200° field of view · ultra-widefield fundus photograph.
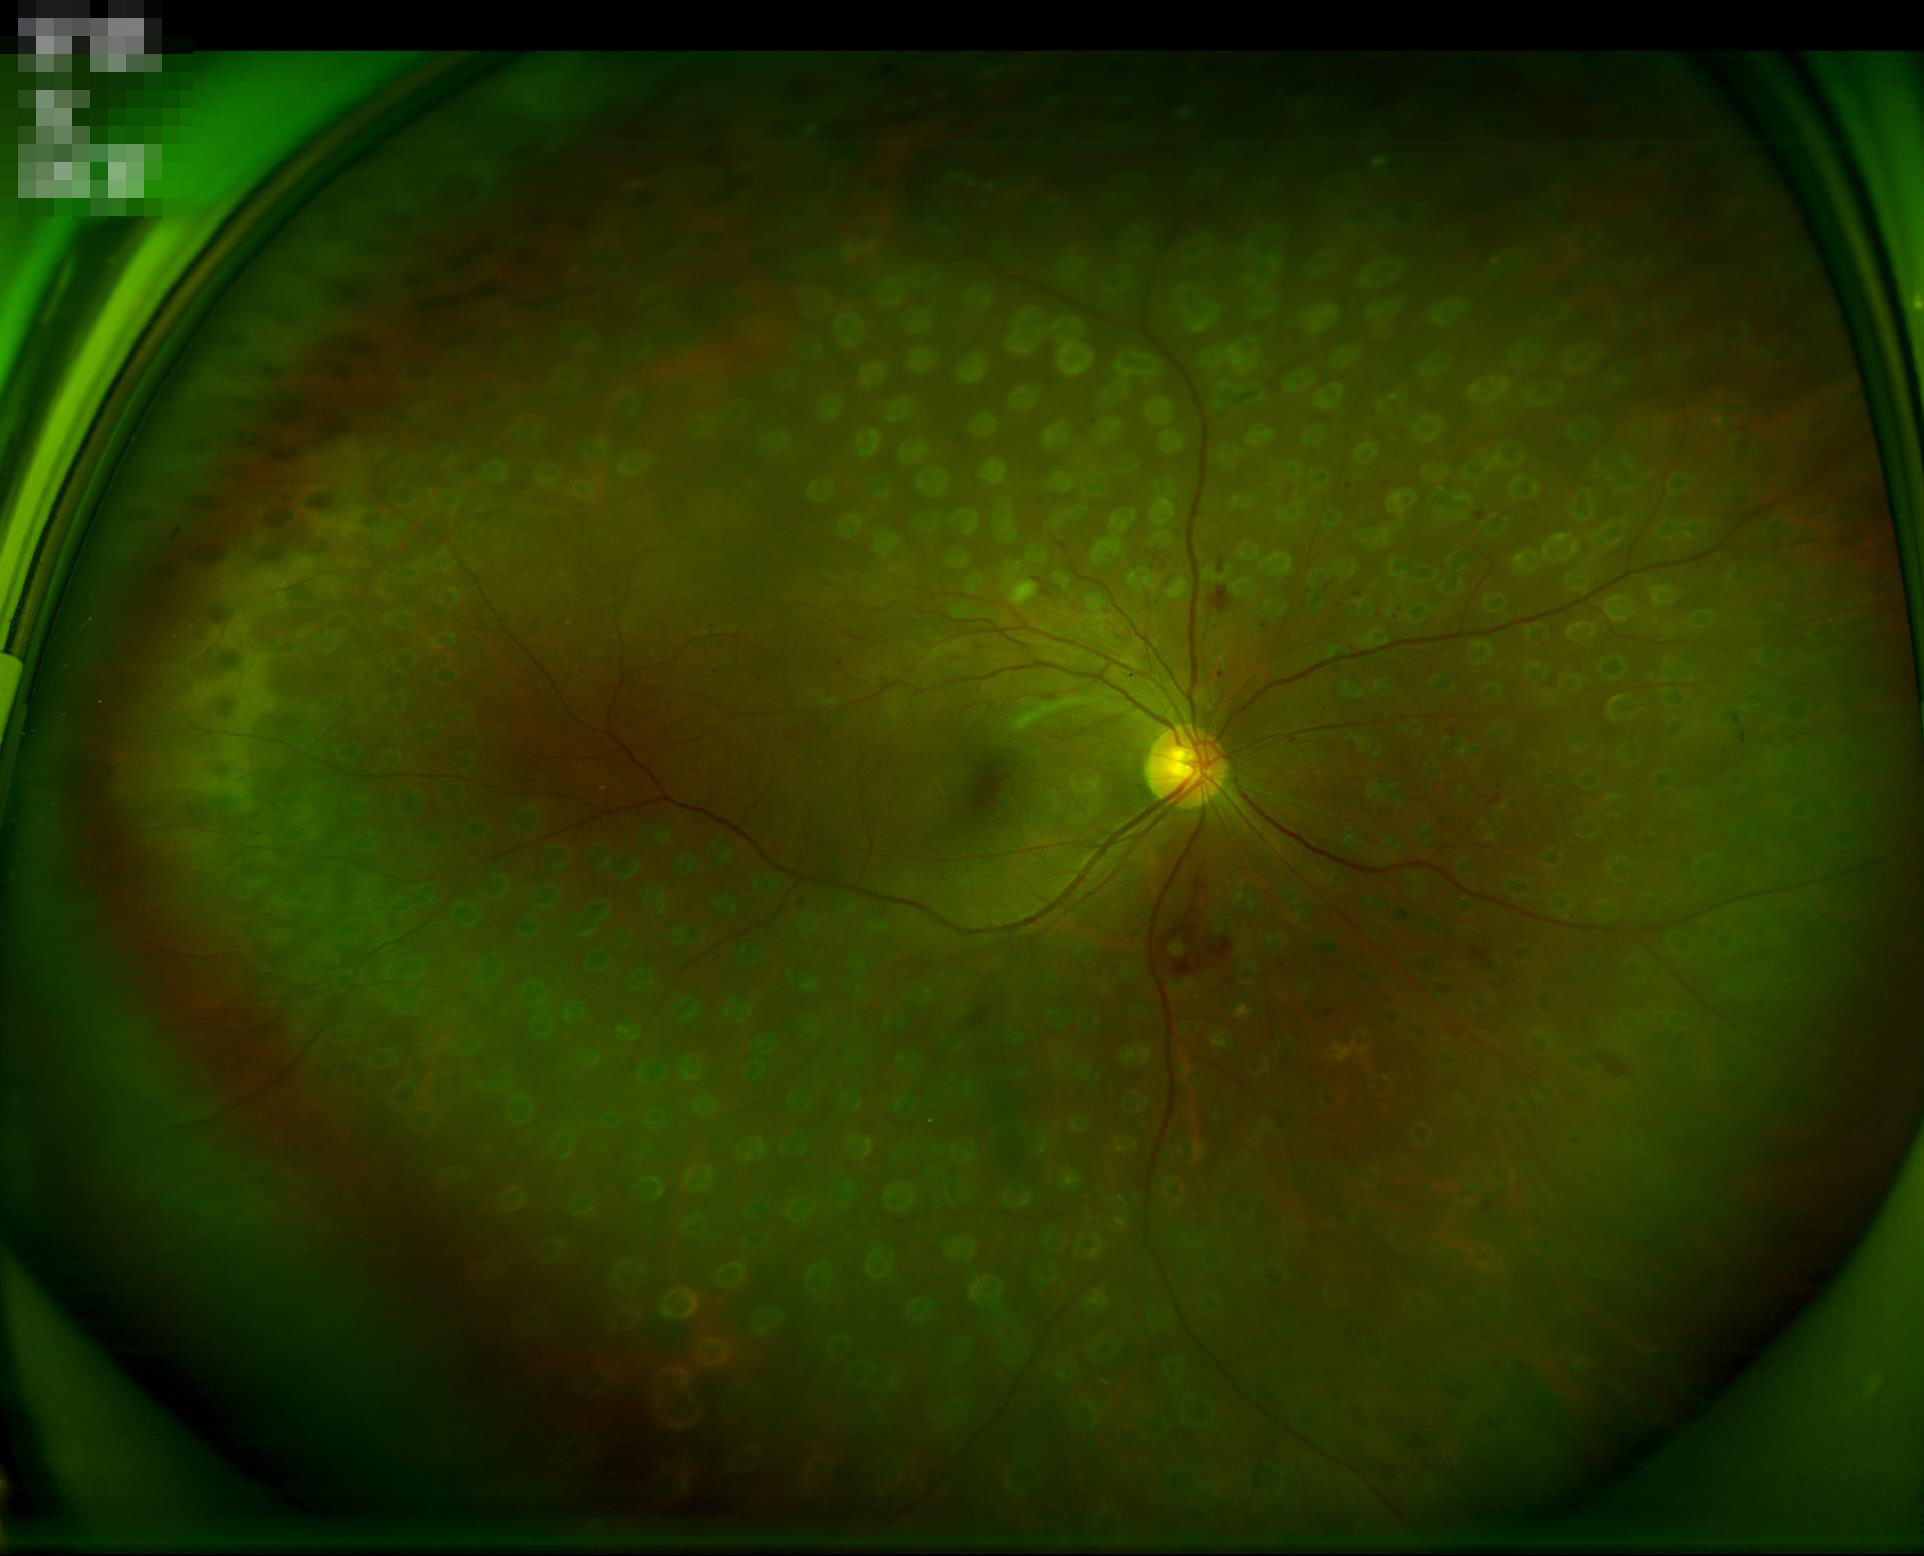
Image quality assessment:
- illumination/color: satisfactory
- focus: clear
- overall: adequate